NIDEK AFC-230: 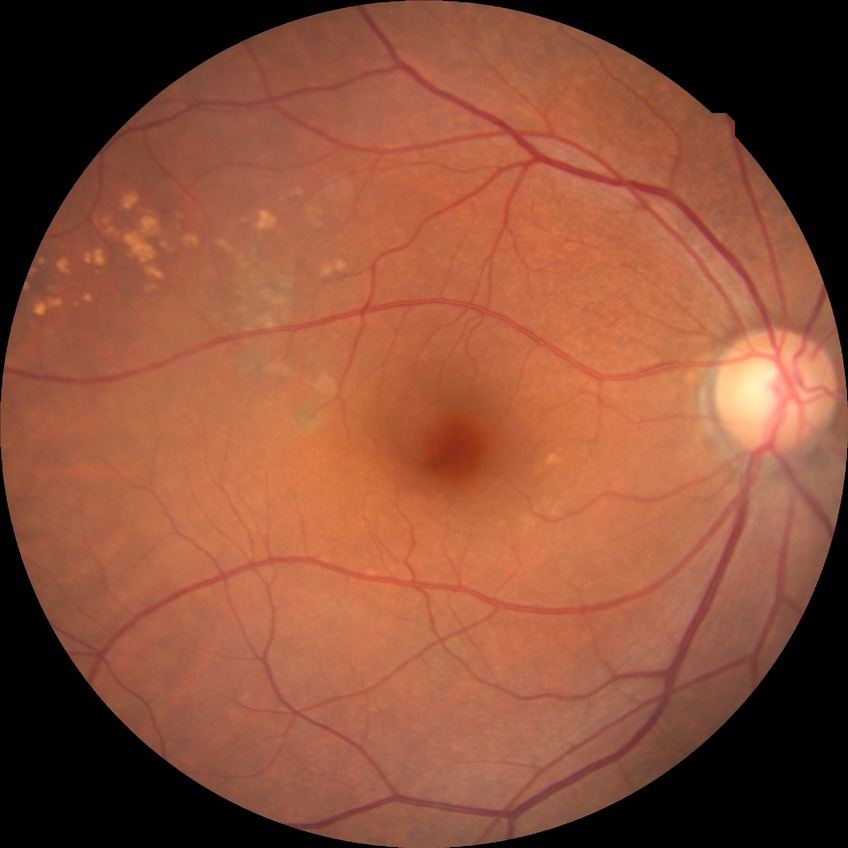
Davis grading is no diabetic retinopathy.